Color fundus photograph. 848x848. 45° field of view. Without pupil dilation. DR severity per modified Davis staging — 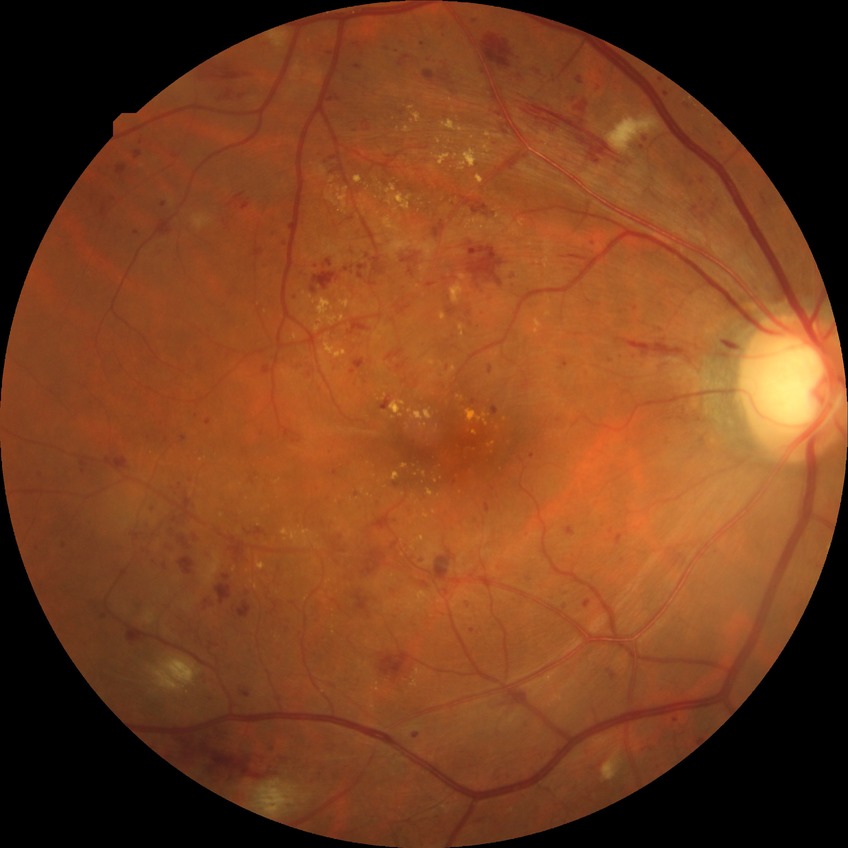
Assessment:
* DR class: non-proliferative diabetic retinopathy
* DR stage: PPDR